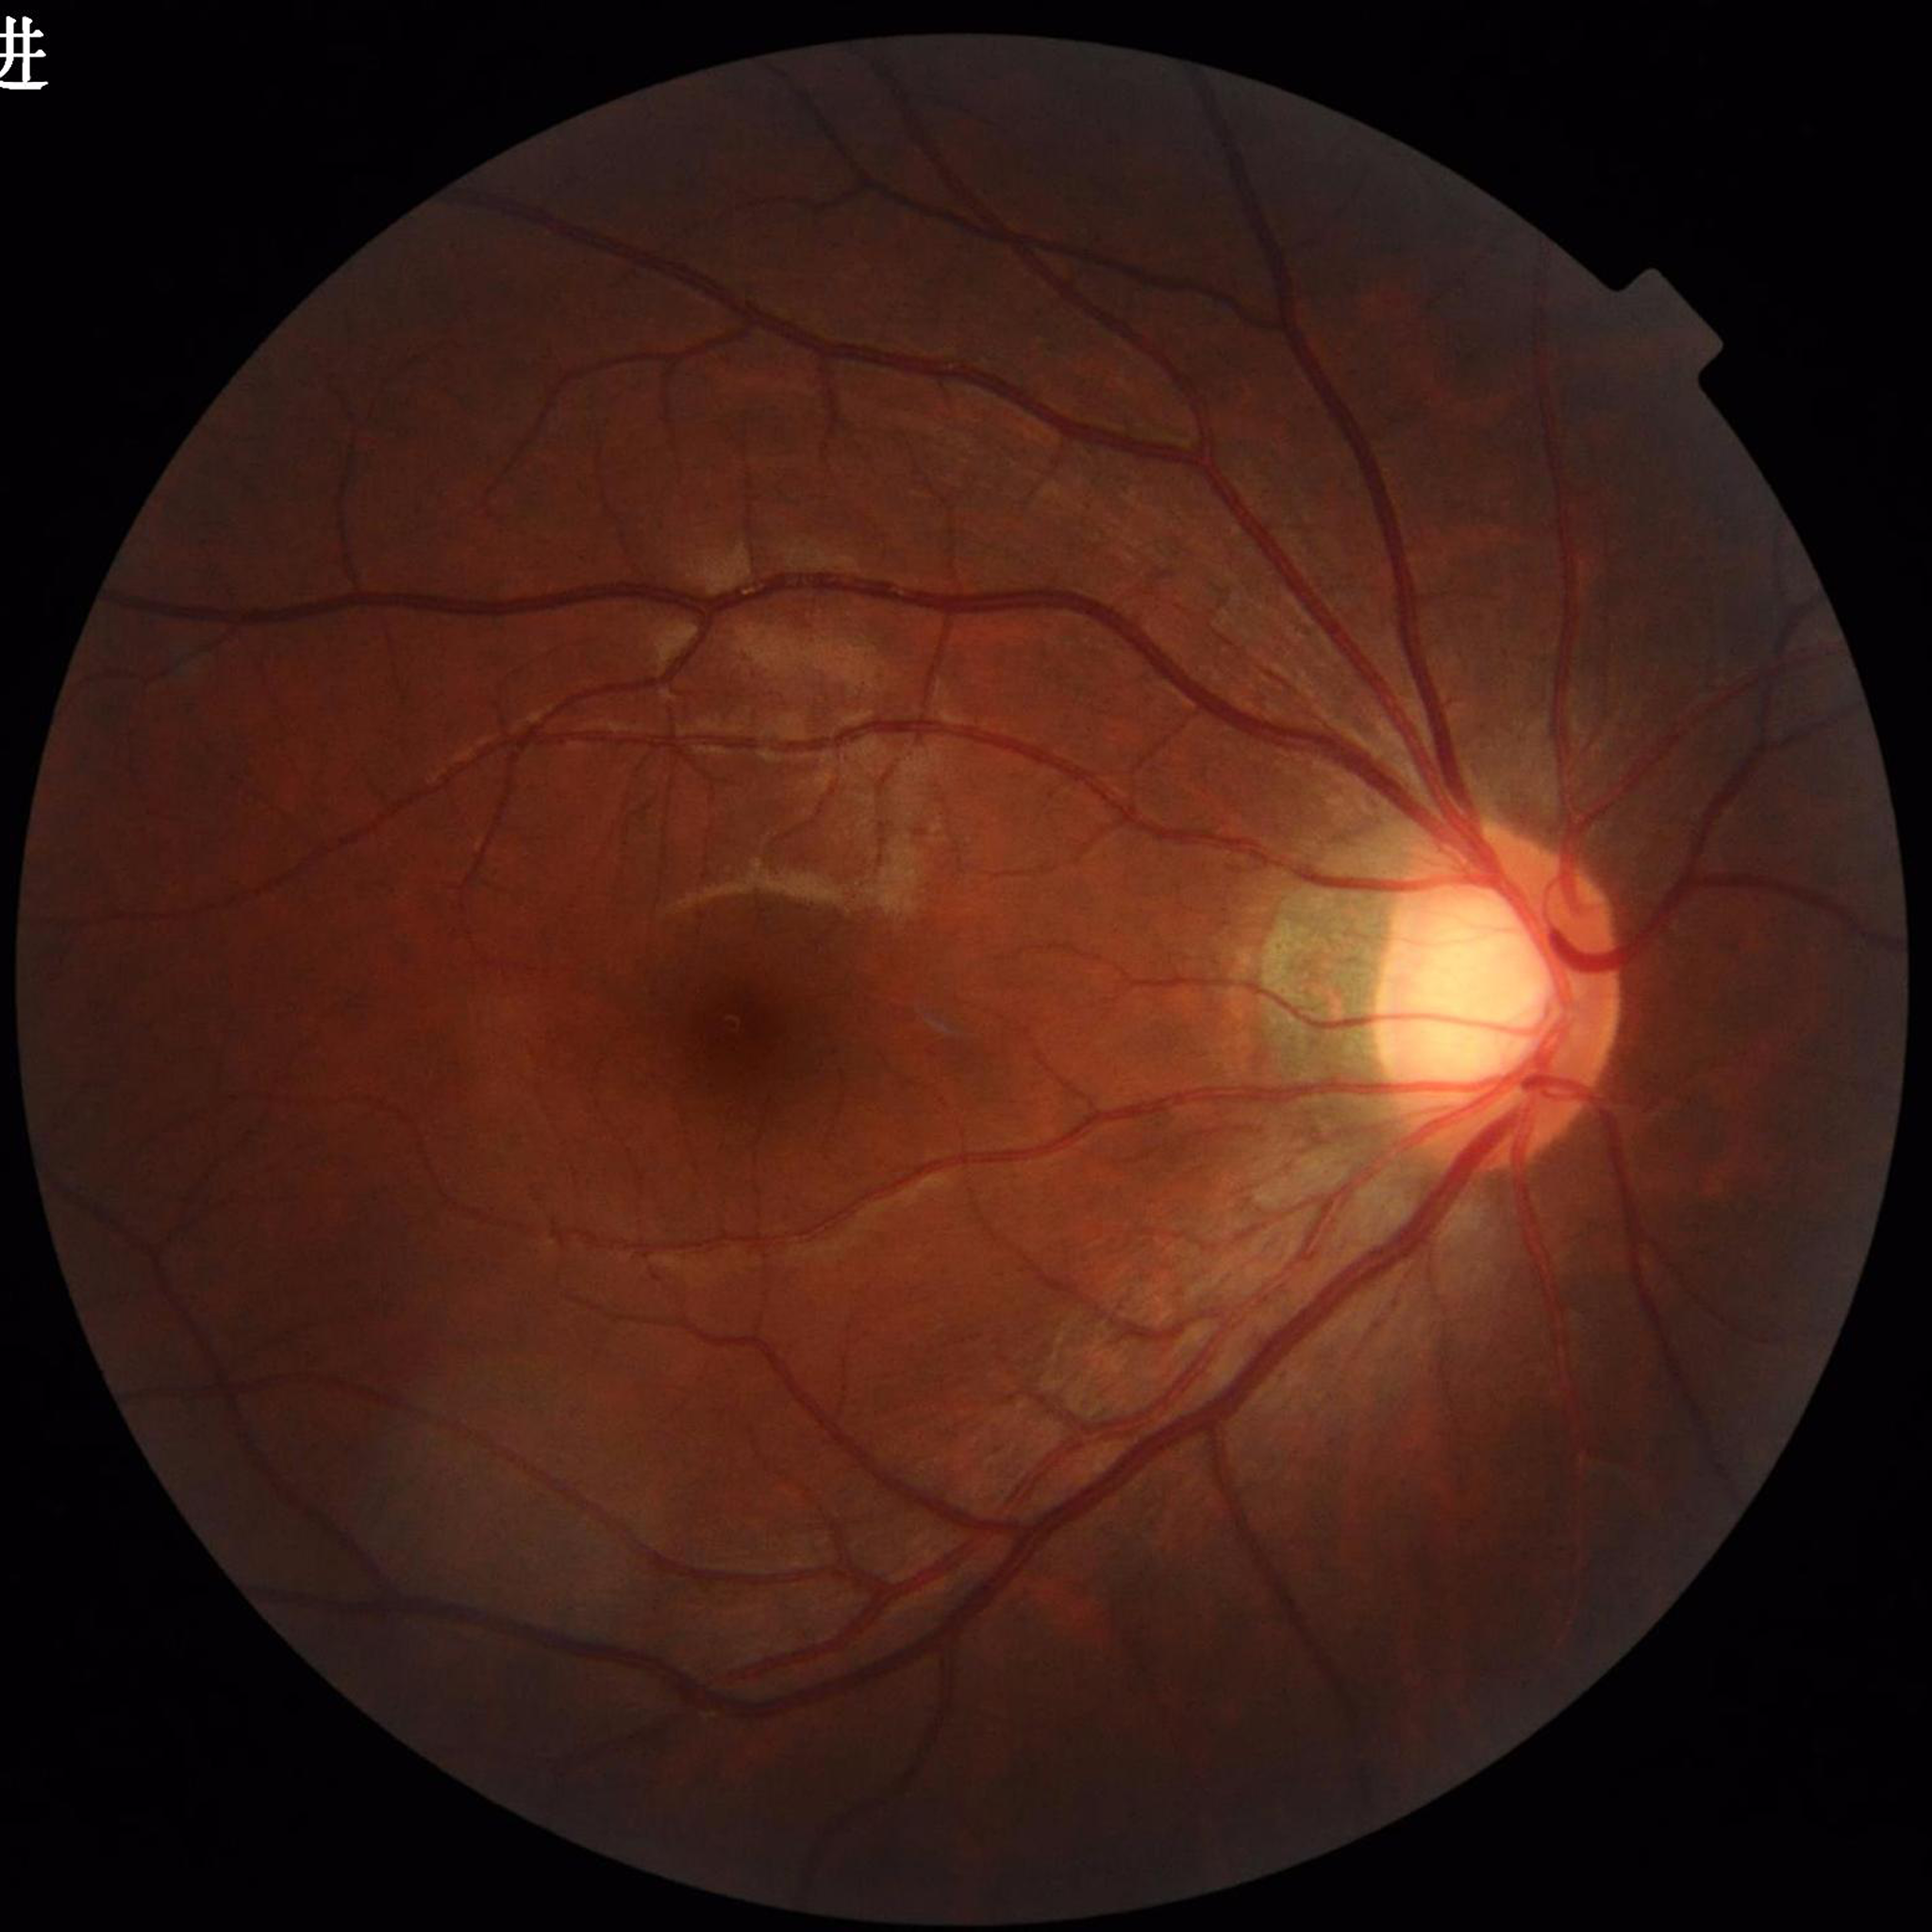 Condition = glaucoma.